45° FOV, 1932 by 1910 pixels, CFP
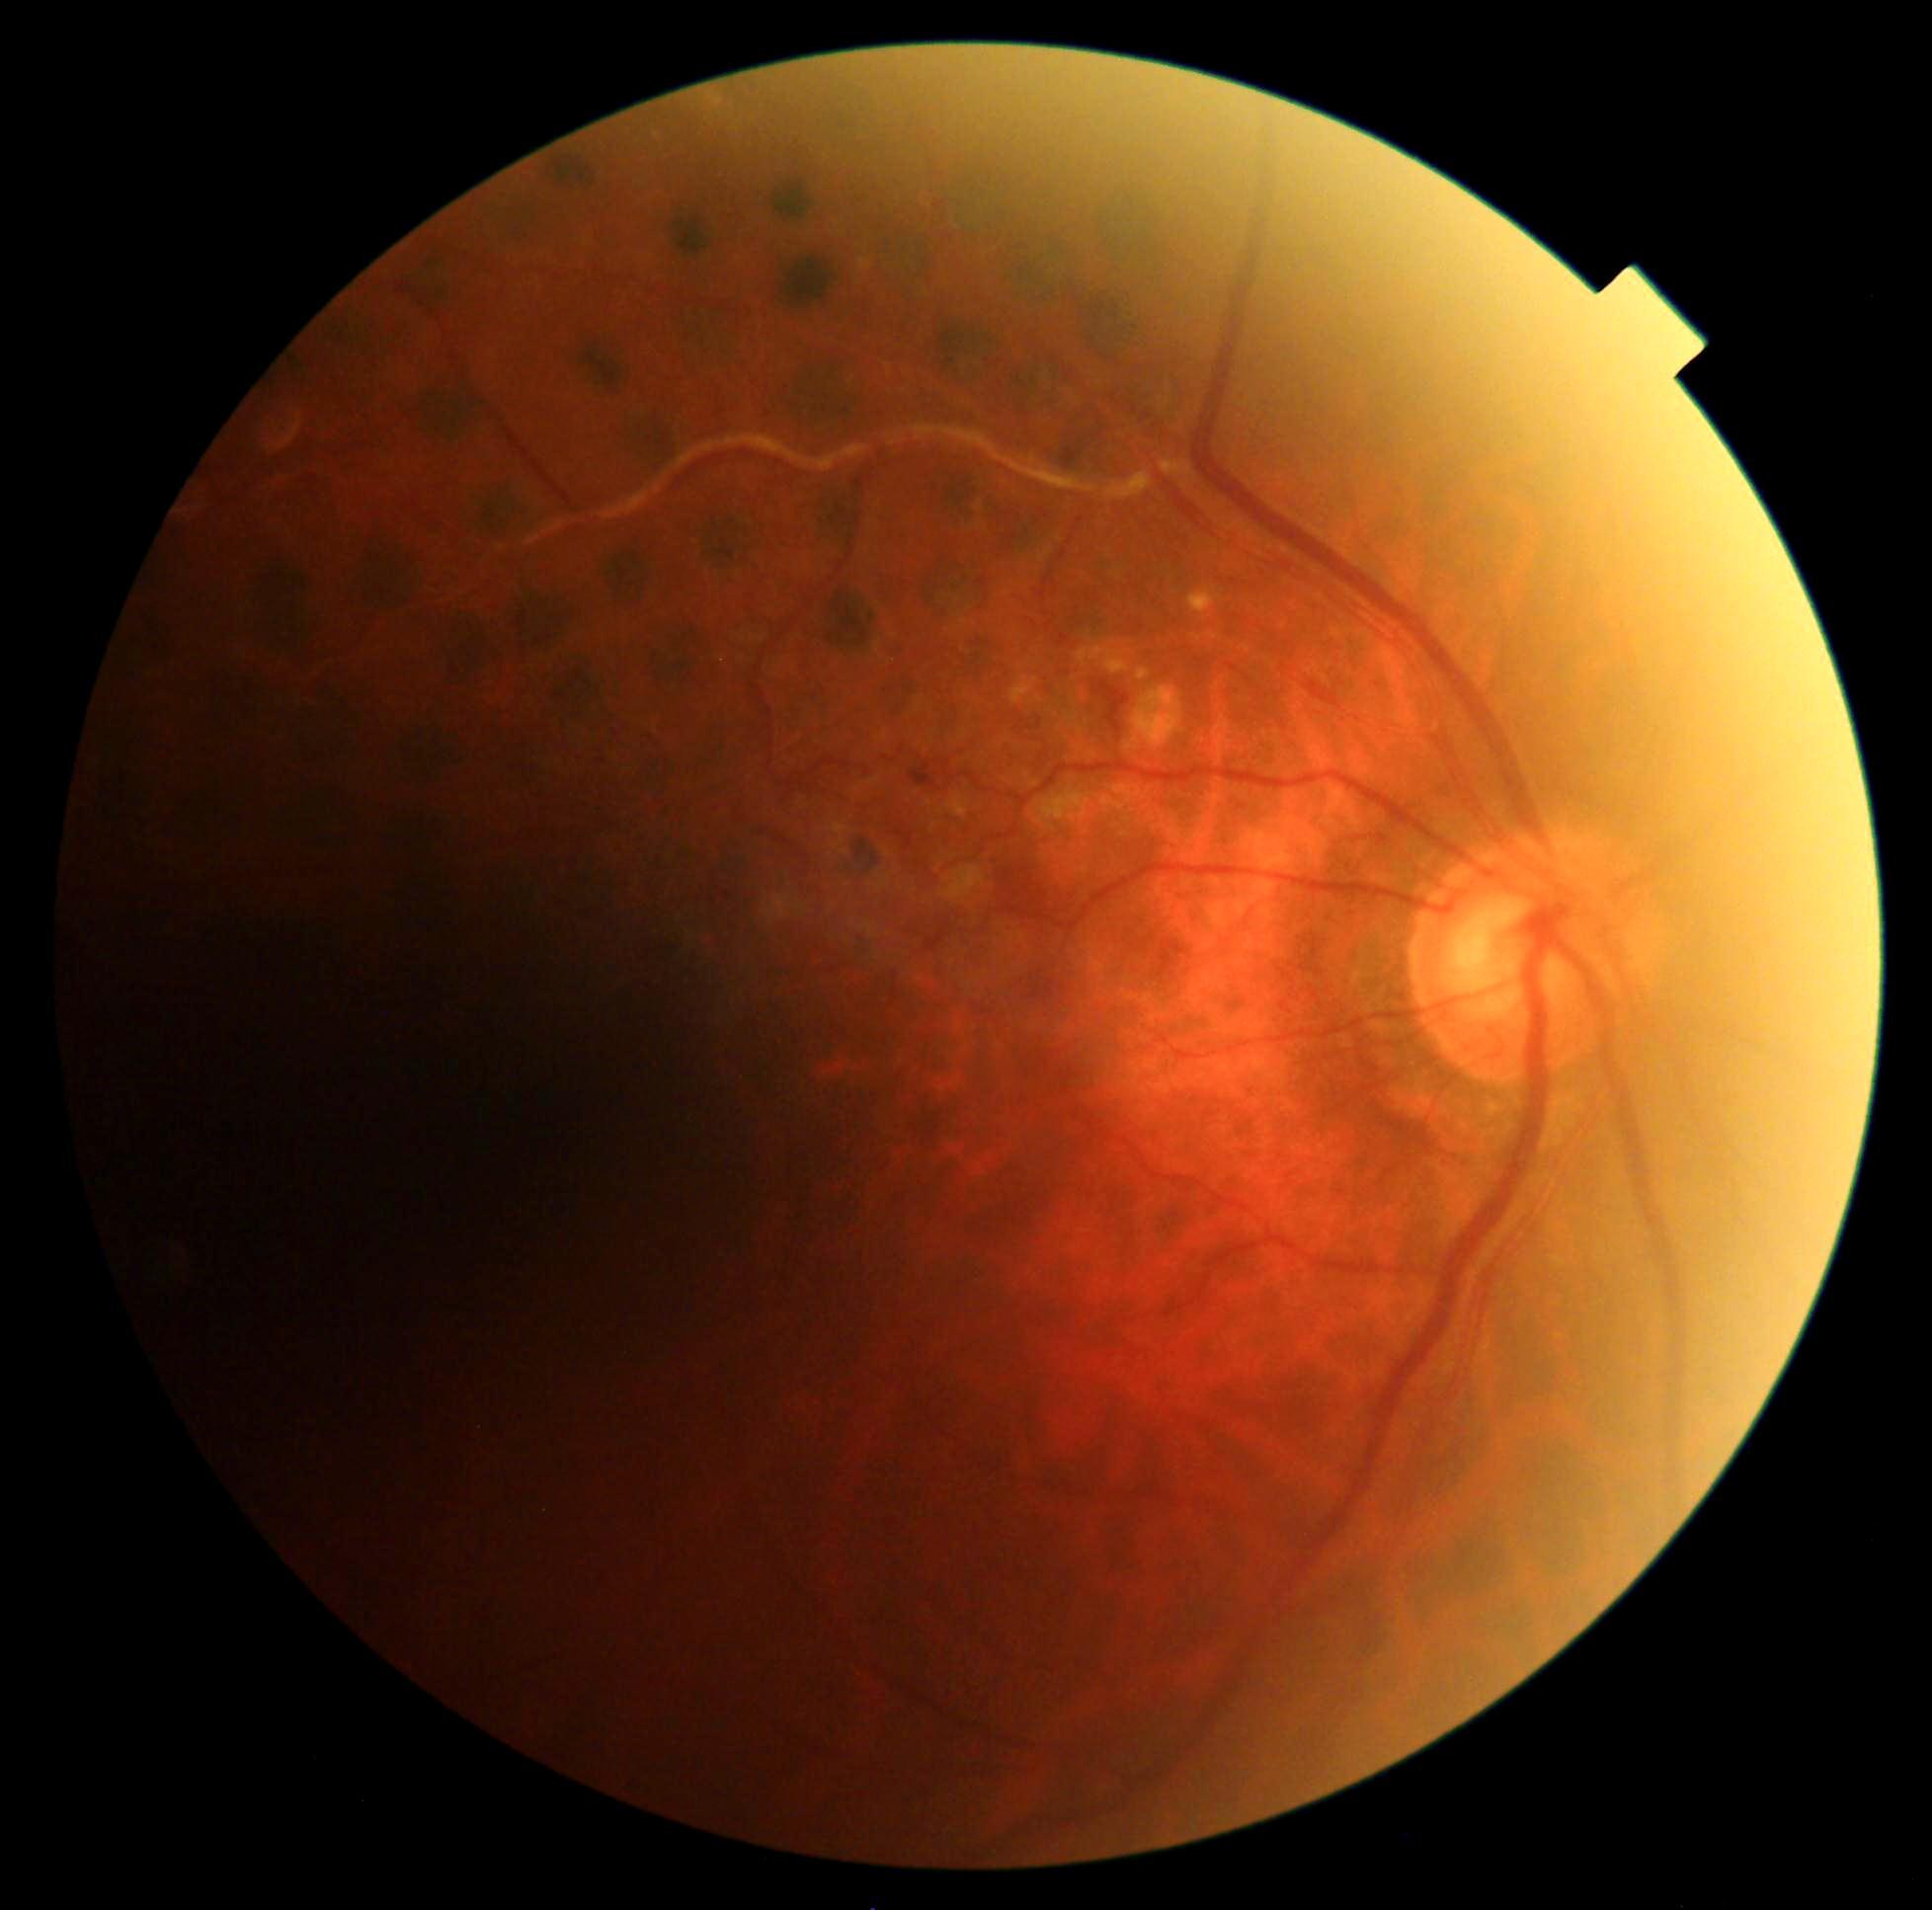
retinopathy grade@2/4 — more than just microaneurysms but less than severe NPDR.